CFP. 45° field of view. 2352 by 1568 pixels
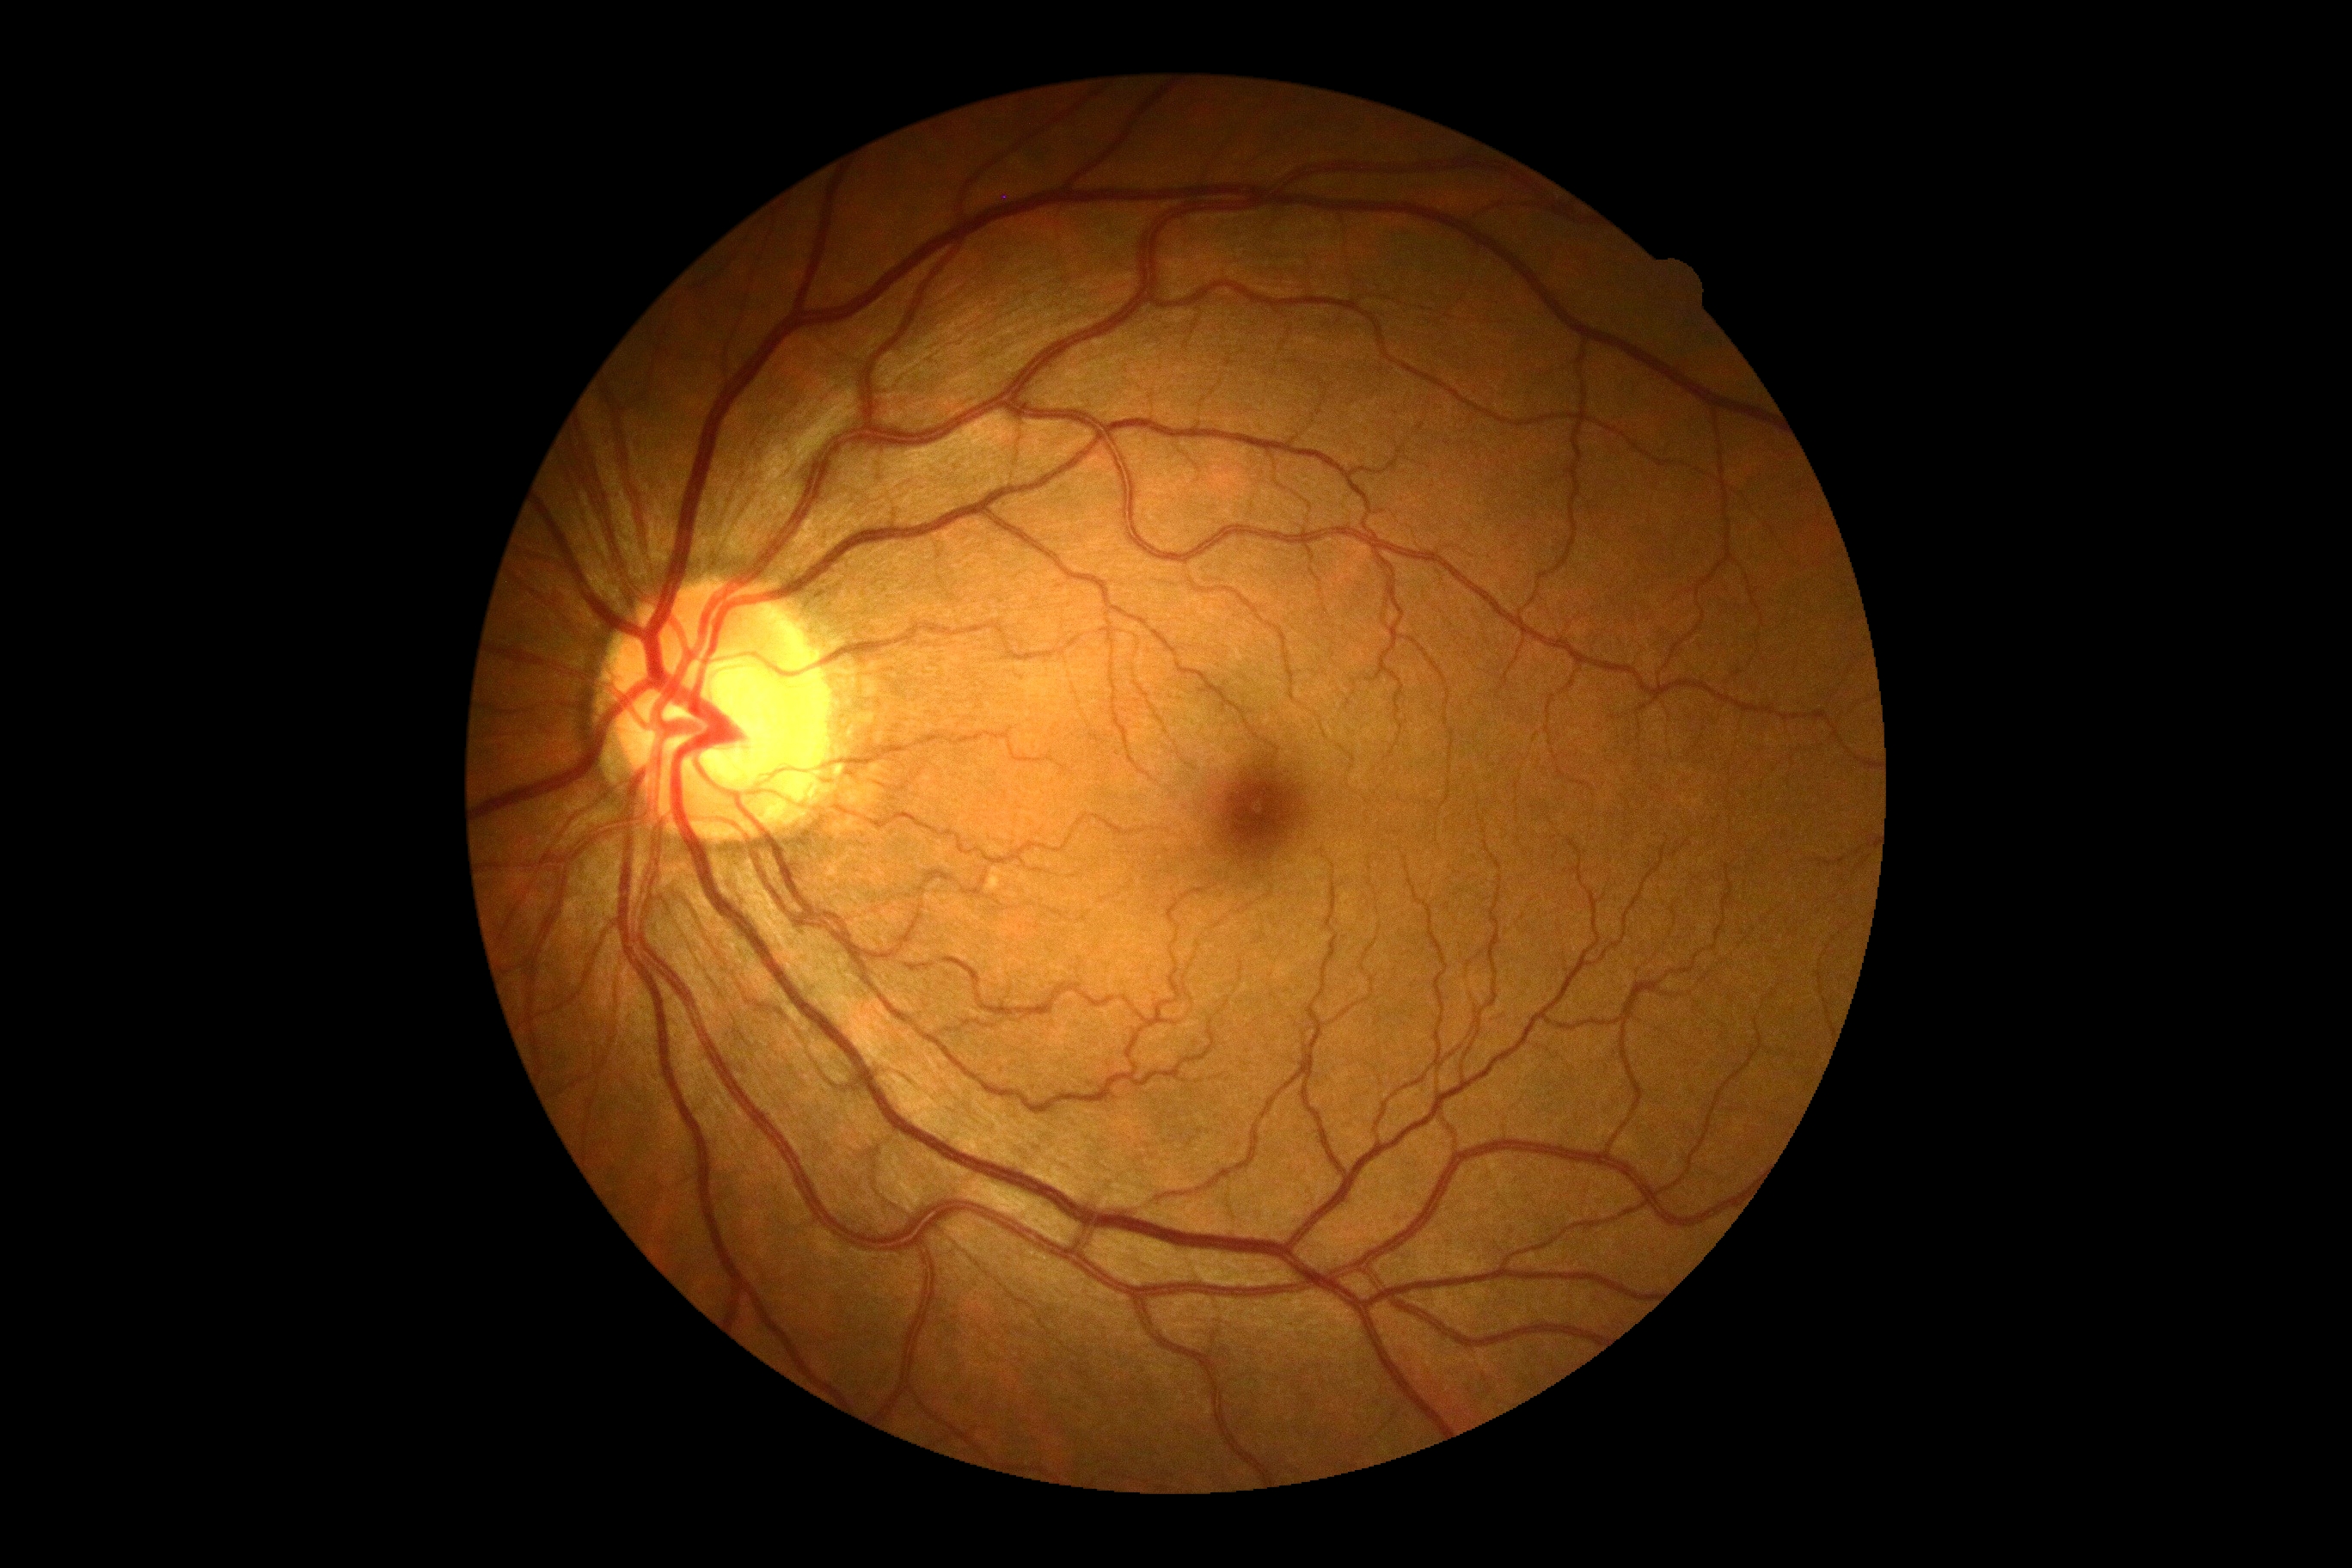

No diabetic retinal disease findings. Diabetic retinopathy (DR) is grade 0.